2352 x 1568 pixels; CFP — 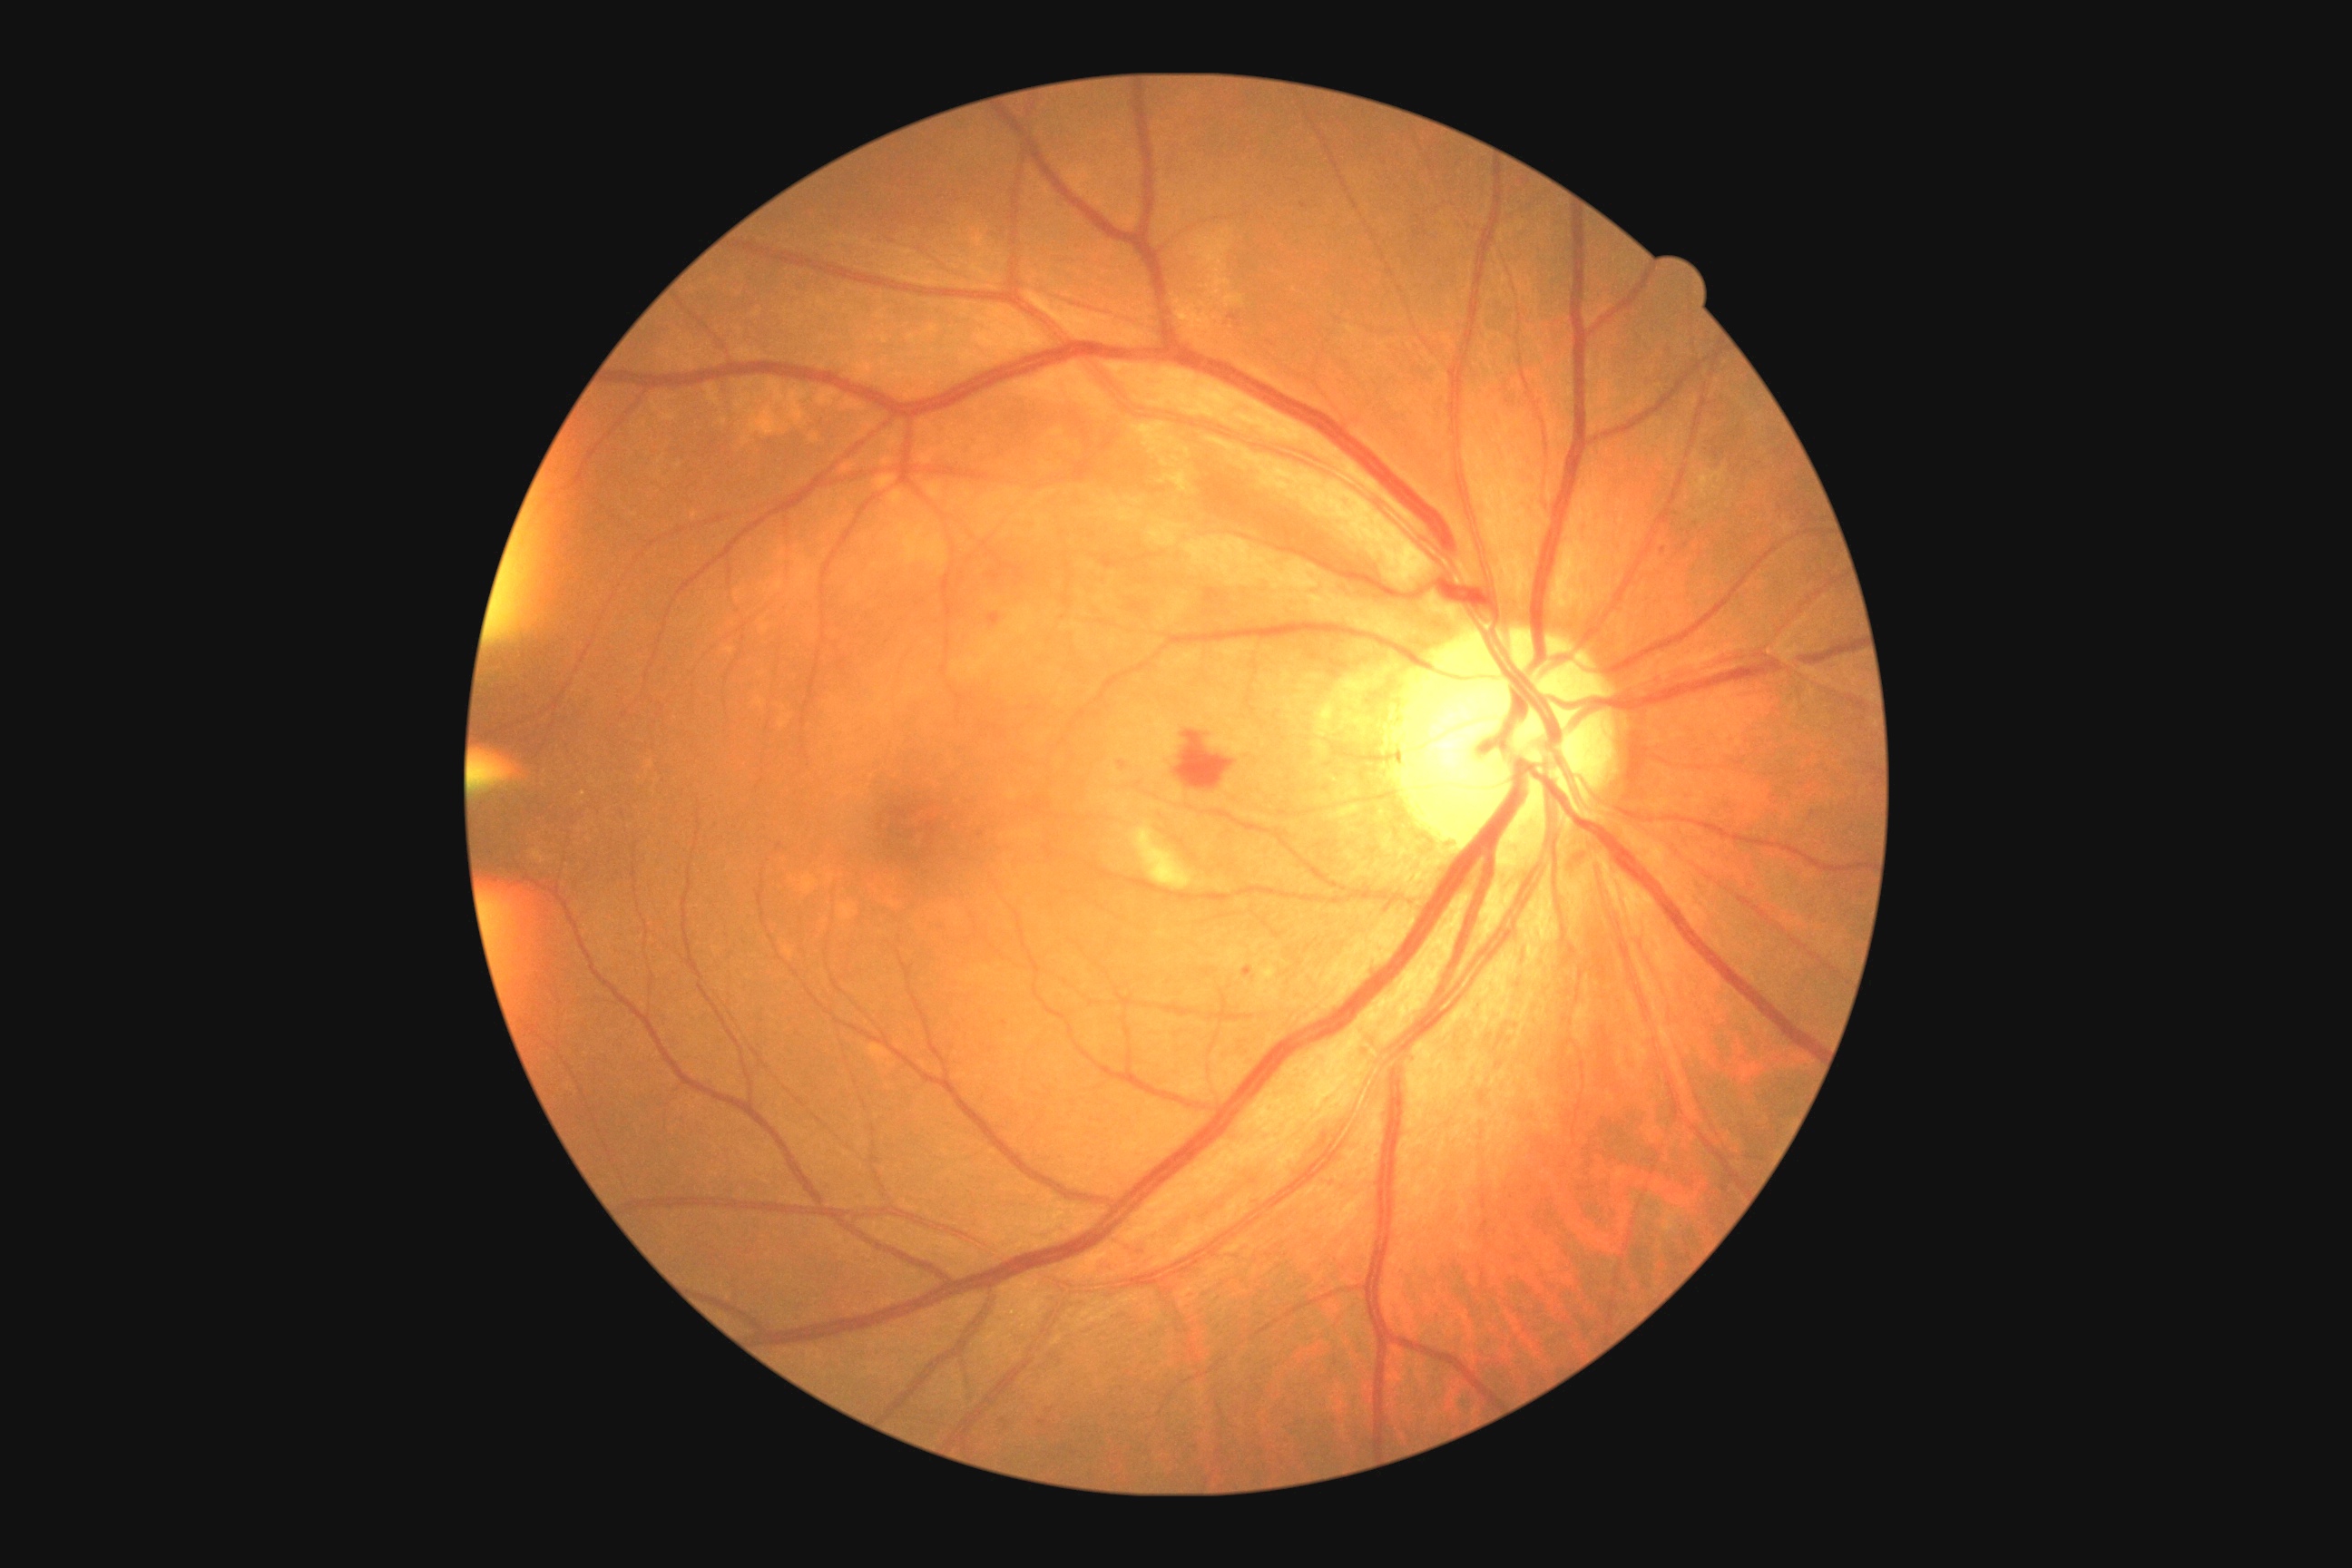

partial: true
dr_grade: 2
dr_grade_name: moderate NPDR
lesions:
  ex: []
  se:
    - [1130,821,1195,890]
  he:
    - [1177,732,1235,790]
  ma:
    - [1300,204,1308,210]
    - [1228,315,1239,322]
    - [1119,761,1126,770]
    - [988,612,1001,625]
    - [1244,966,1253,977]
  ma_small_centers:
    - (1042; 1422)
    - (982; 835)
    - (1003; 1421)
    - (1662; 550)